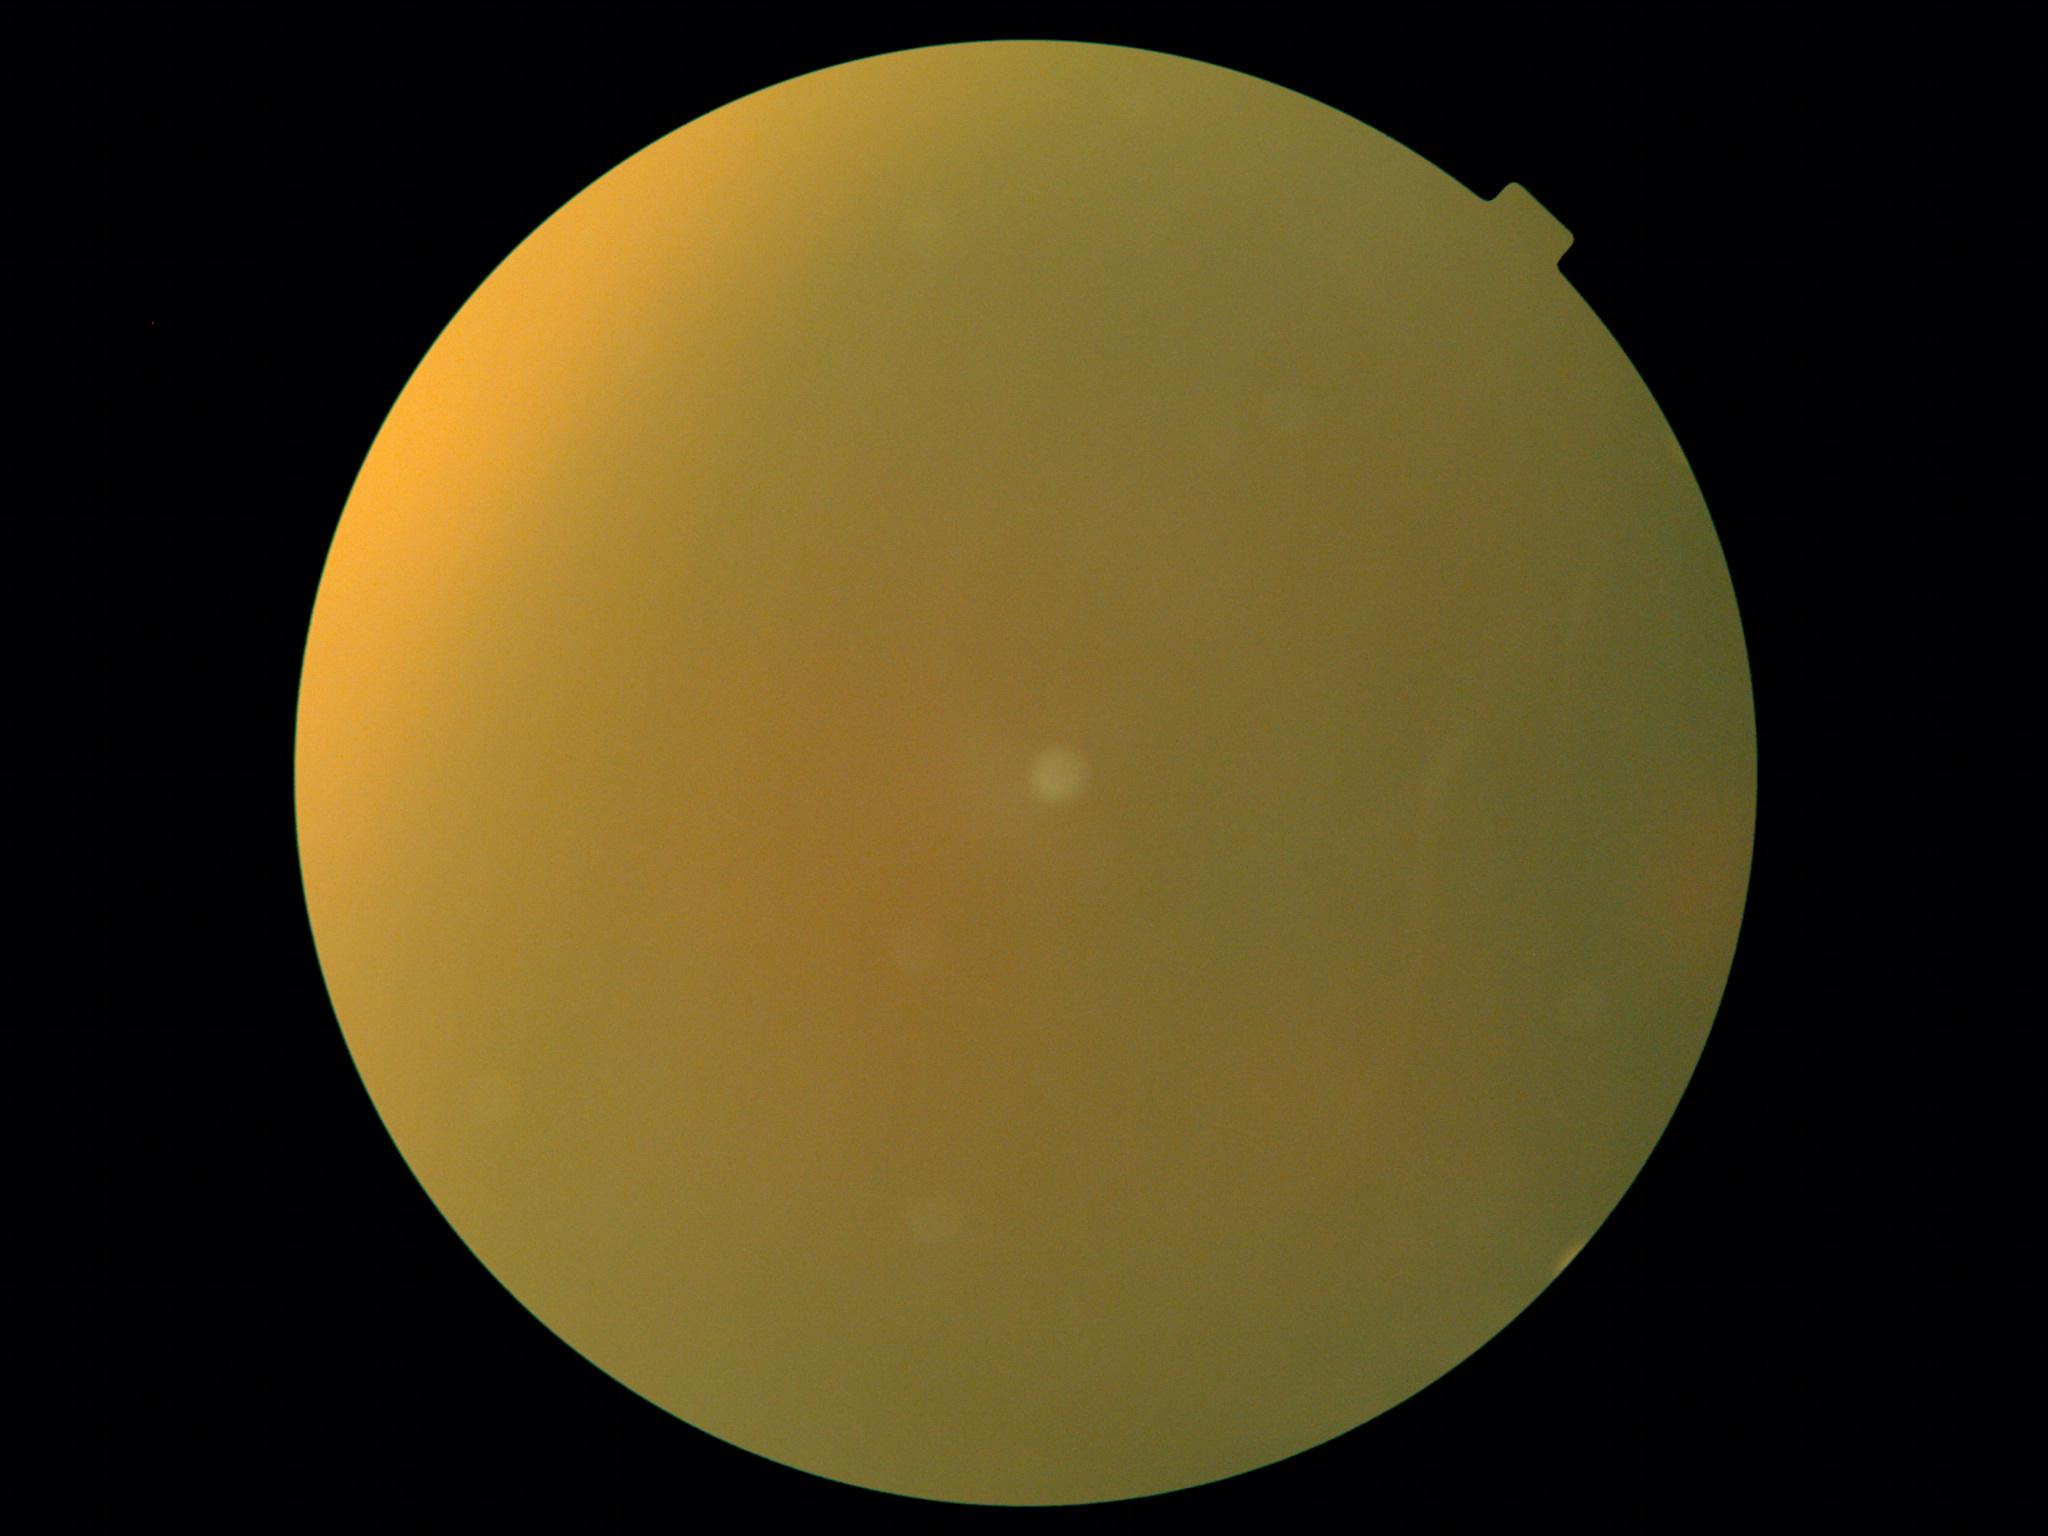 dr_grade: ungradable due to poor image quality